Color fundus photograph
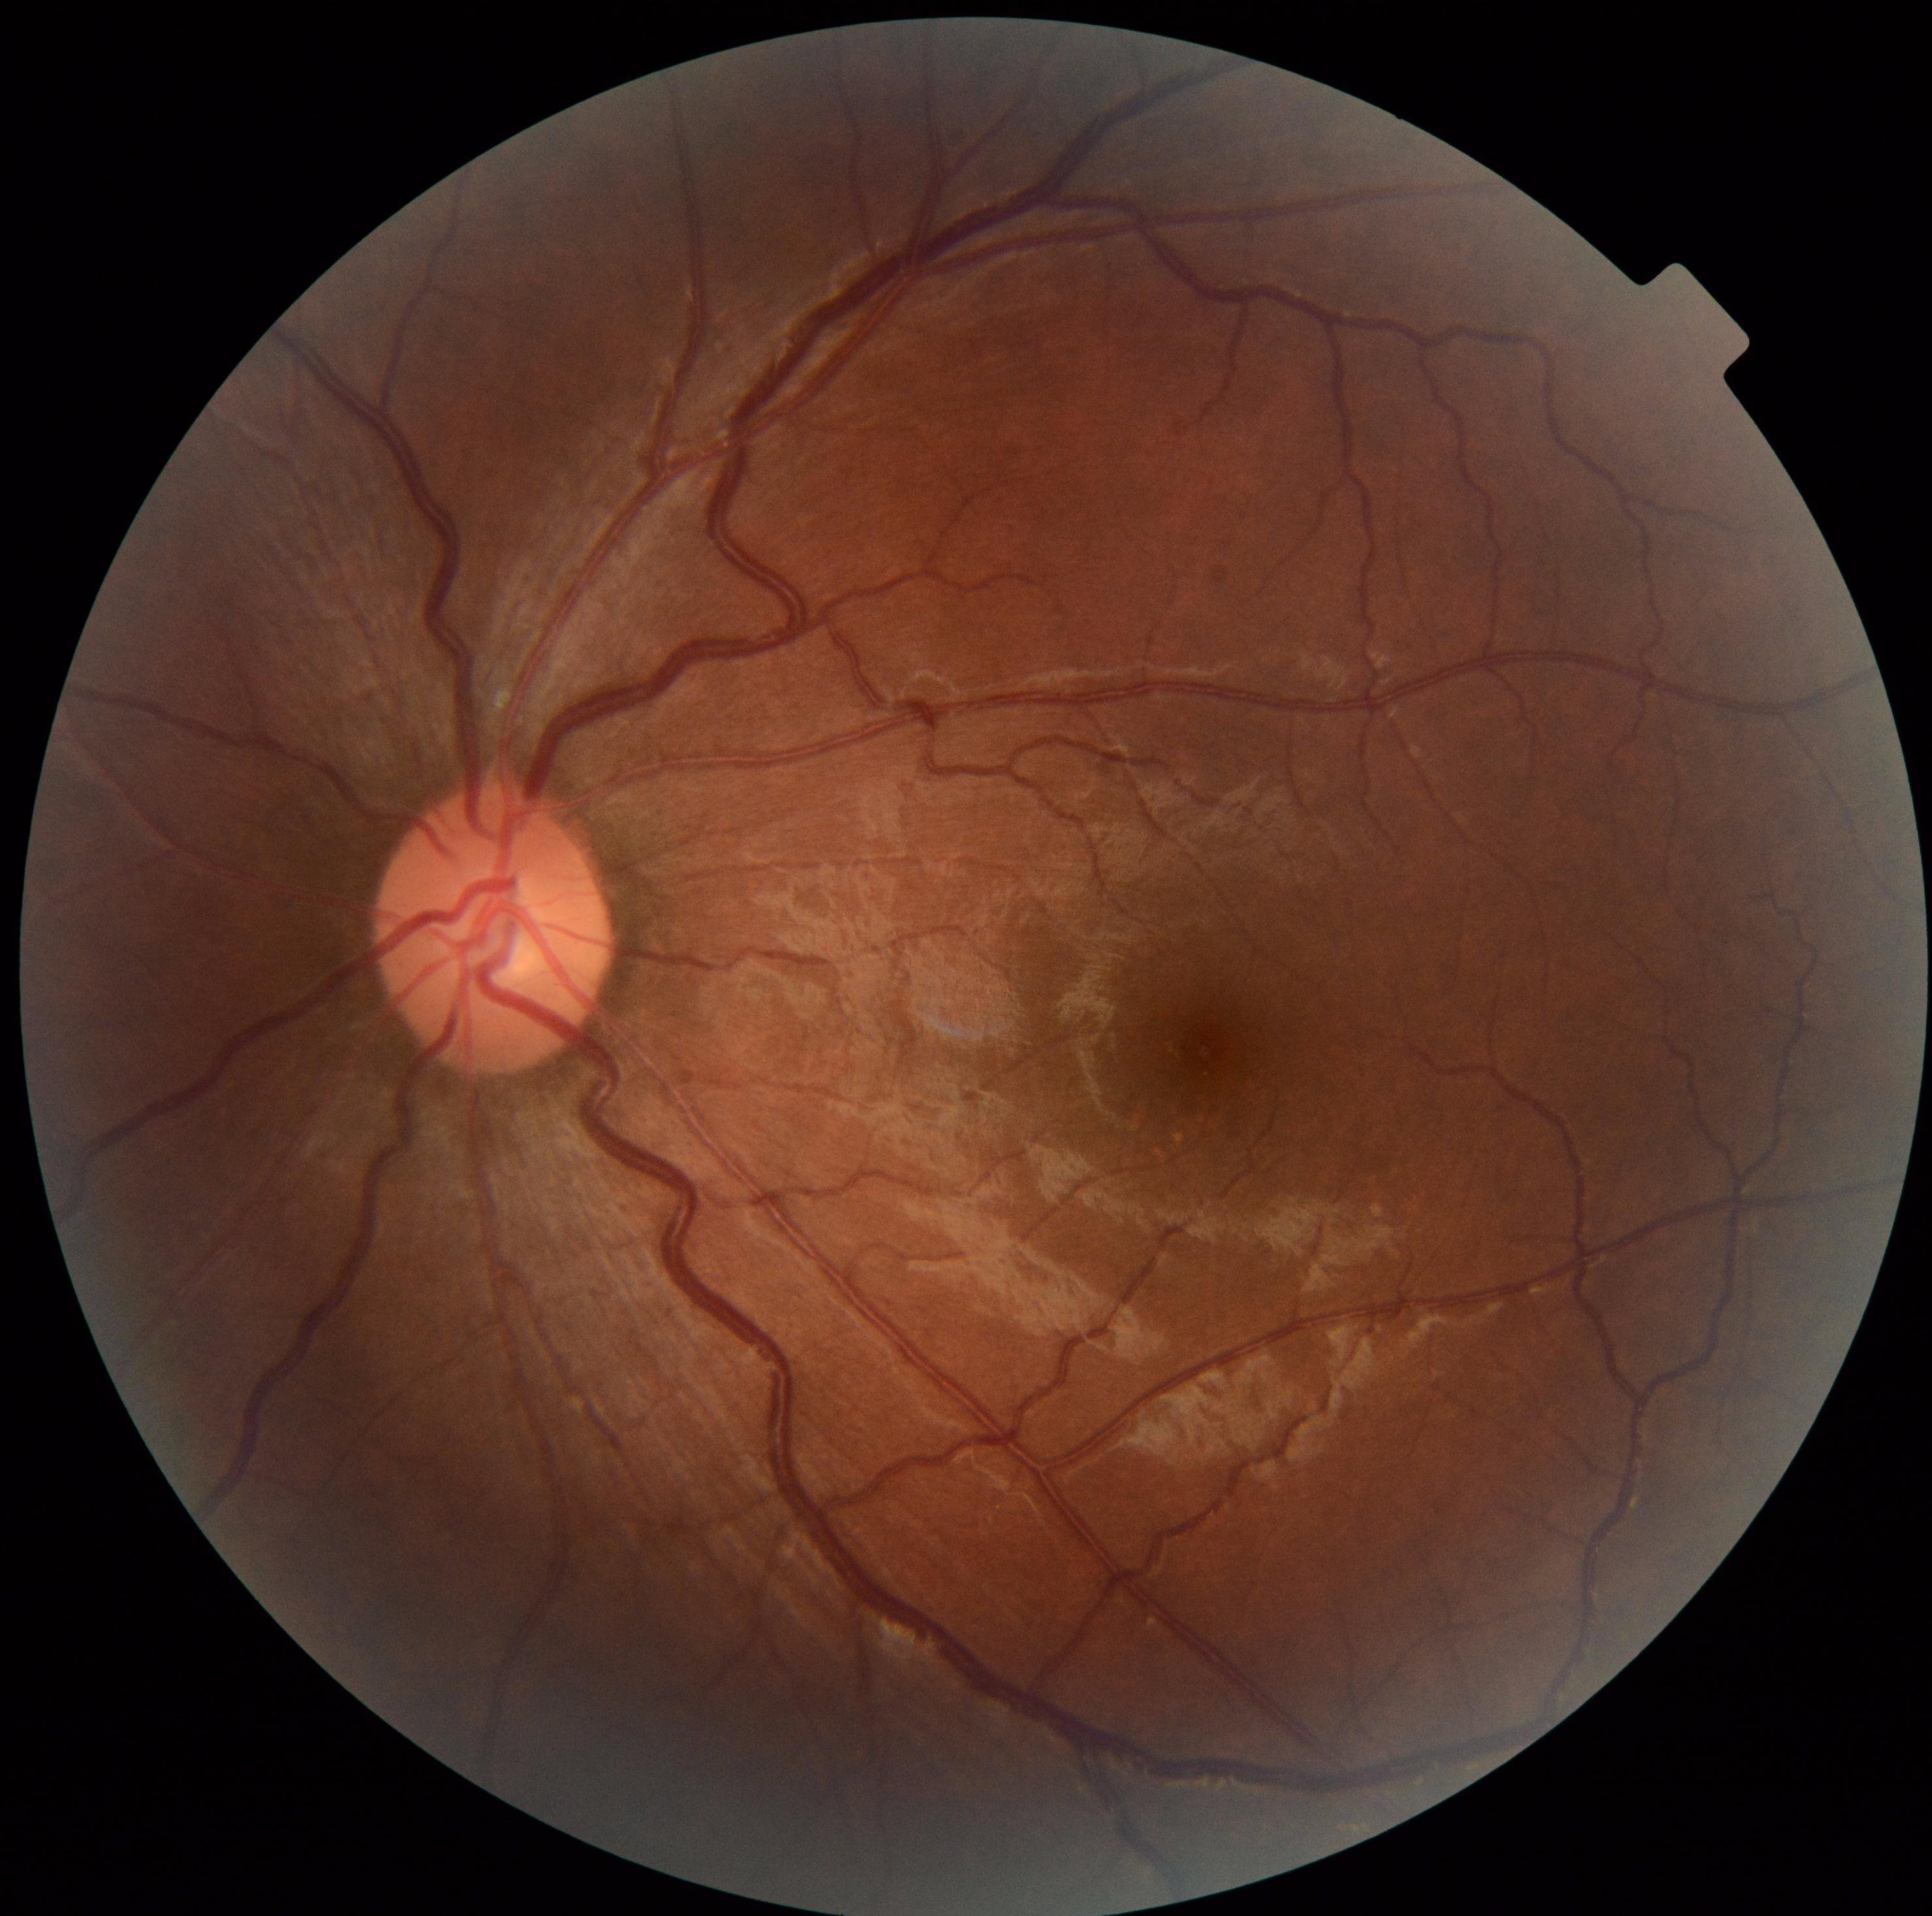 Diabetic retinopathy grade: 0 (no apparent retinopathy).
No DR findings.